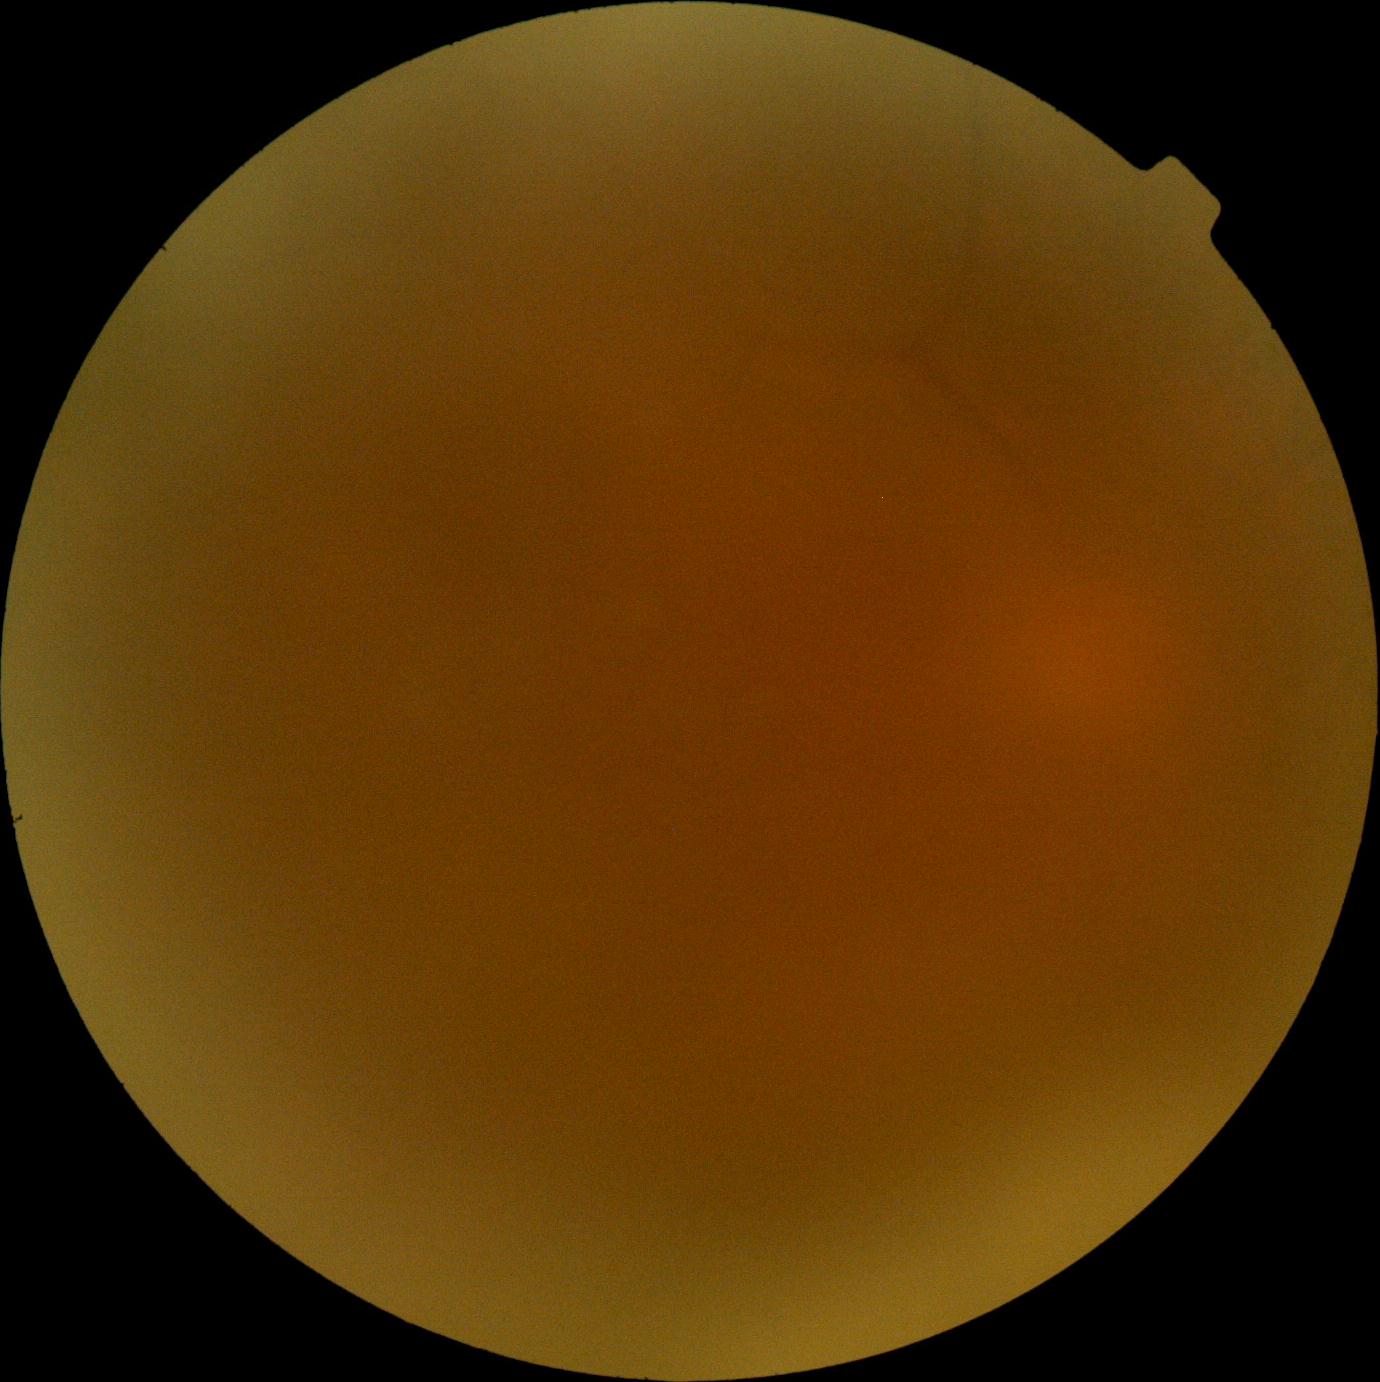 DR@ungradable.